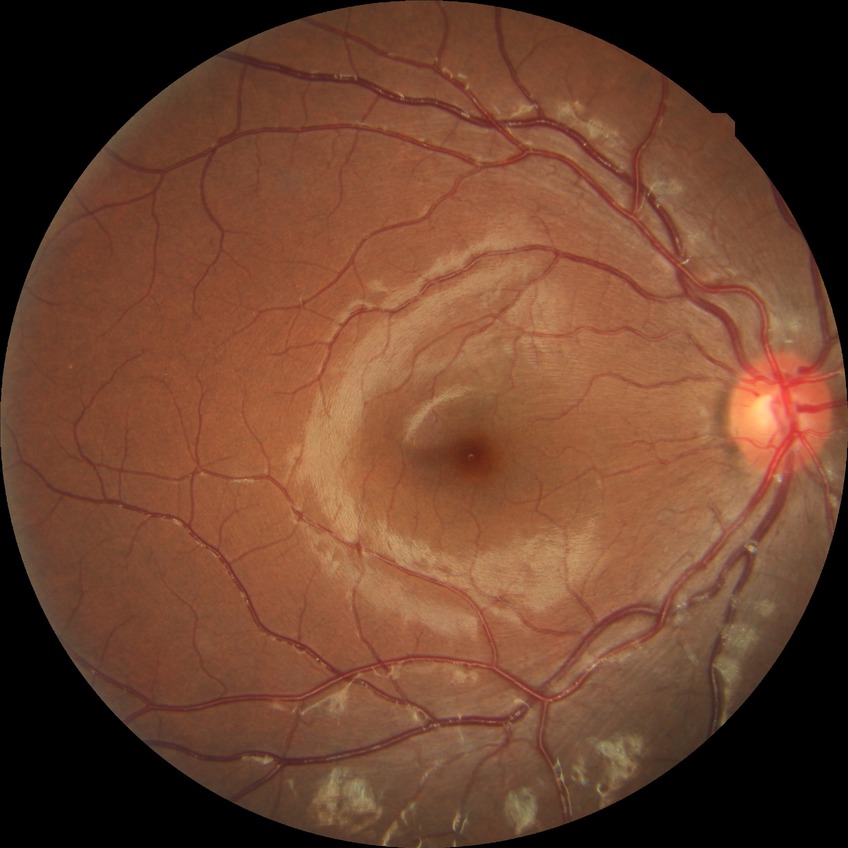

diabetic retinopathy (DR) = SDR (simple diabetic retinopathy).